45-degree field of view.
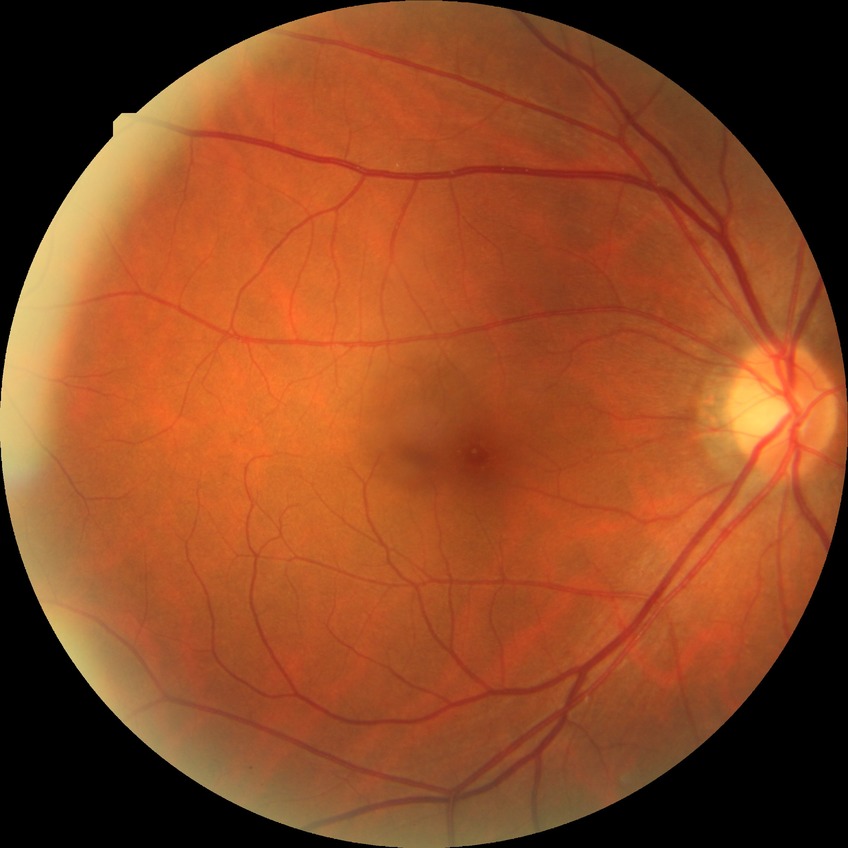
- DR stage — SDR
- DR class — non-proliferative diabetic retinopathy